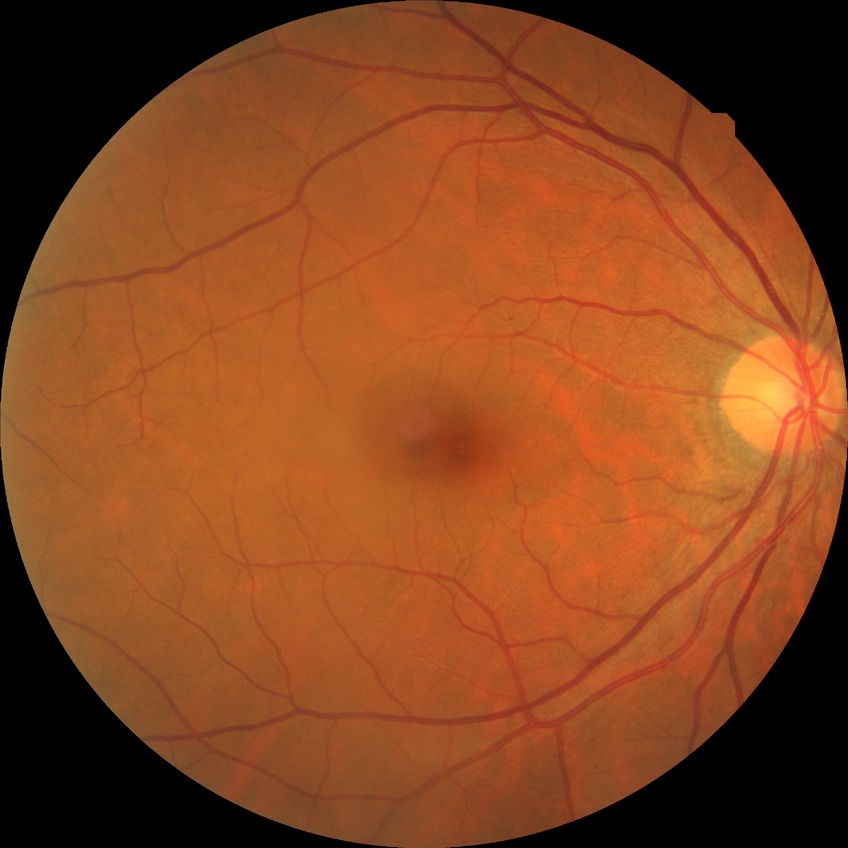 diabetic retinopathy (DR)=no diabetic retinopathy (NDR).